Camera: NIDEK AFC-230 · 45° field of view · no pharmacologic dilation: 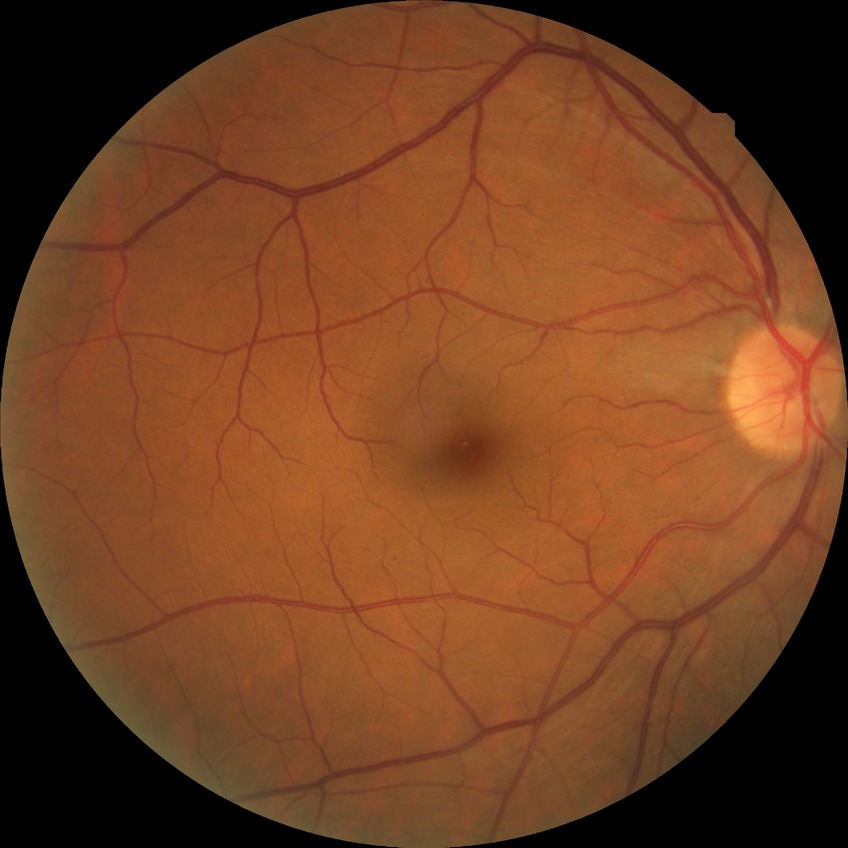
Modified Davis grading: simple diabetic retinopathy.